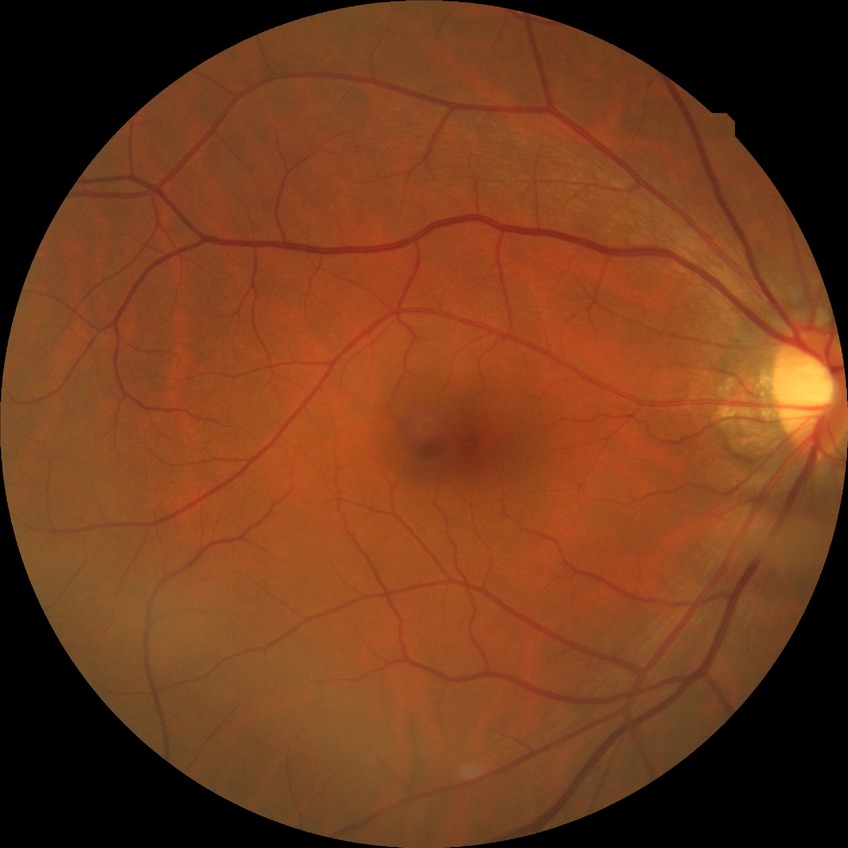
Annotations:
• modified Davis grade: NDR
• DR impression: negative for DR